Disc-centered field, captured on a Nidek AFC-330 fundus camera.
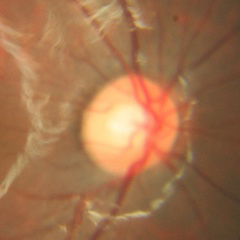
Findings consistent with no glaucomatous optic neuropathy.